Color fundus photograph; 2352 x 1568 pixels; FOV: 45 degrees:
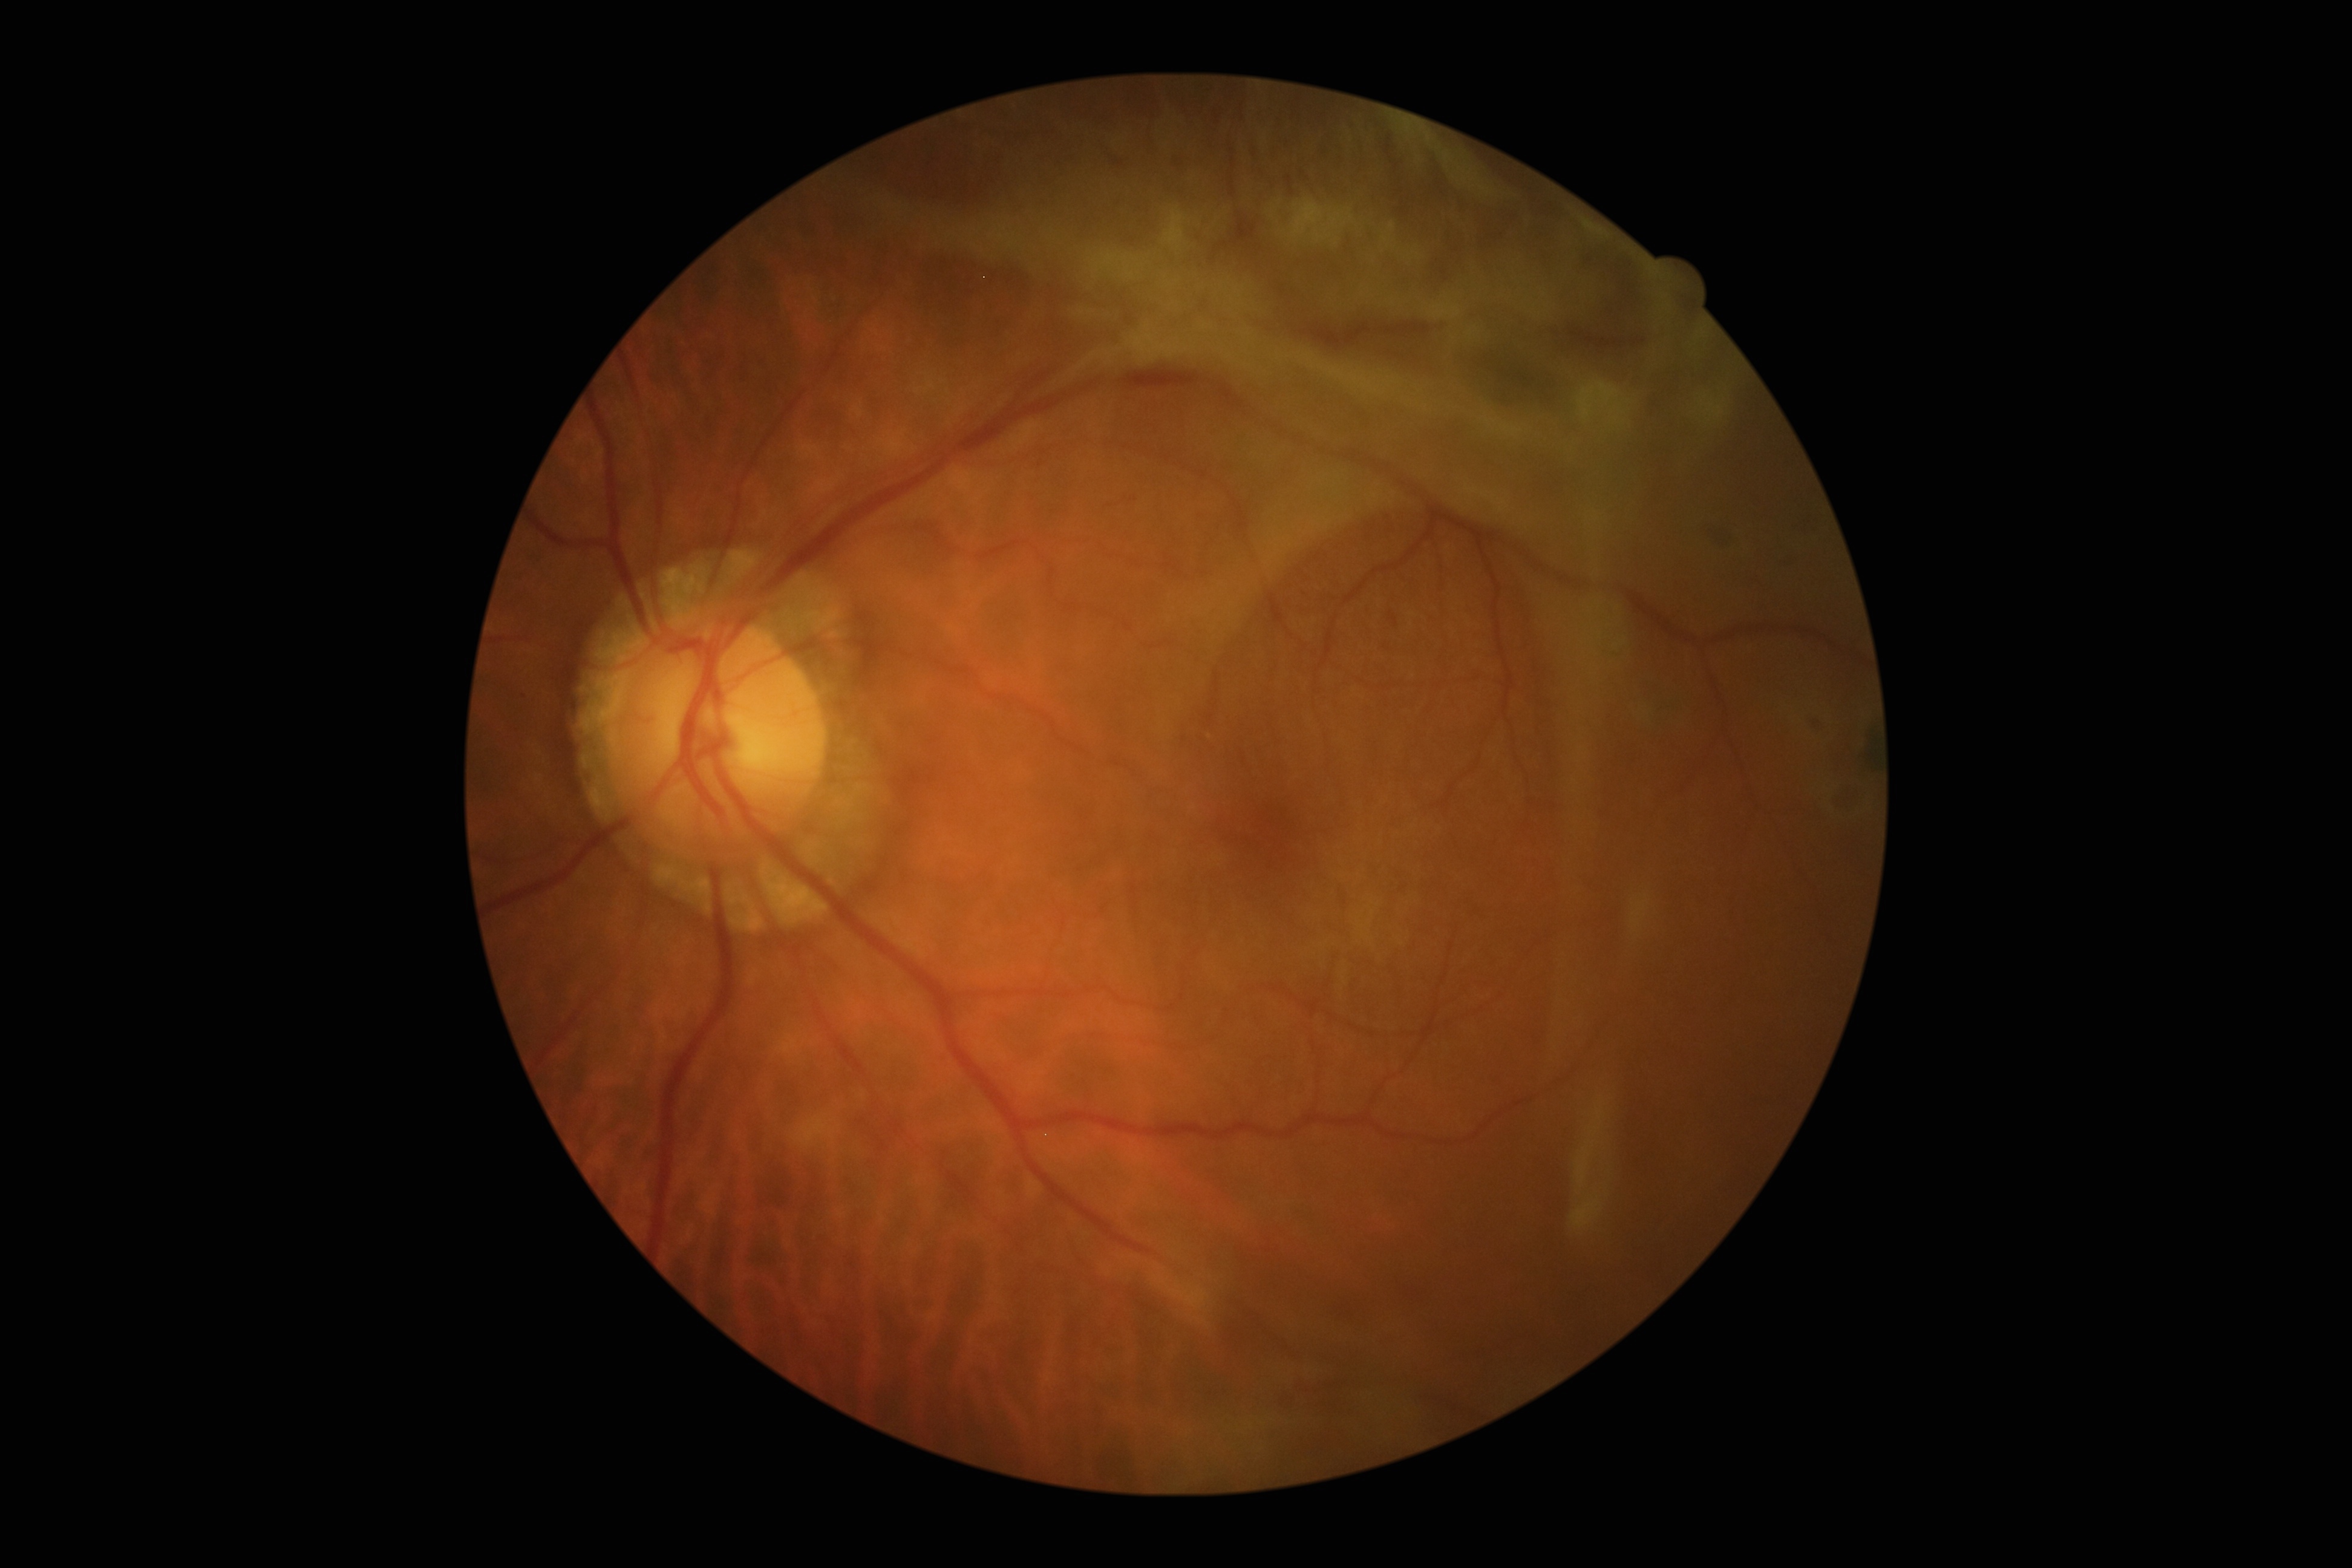 Diabetic retinopathy is grade 4.